Camera: Topcon TRC-NW8 — 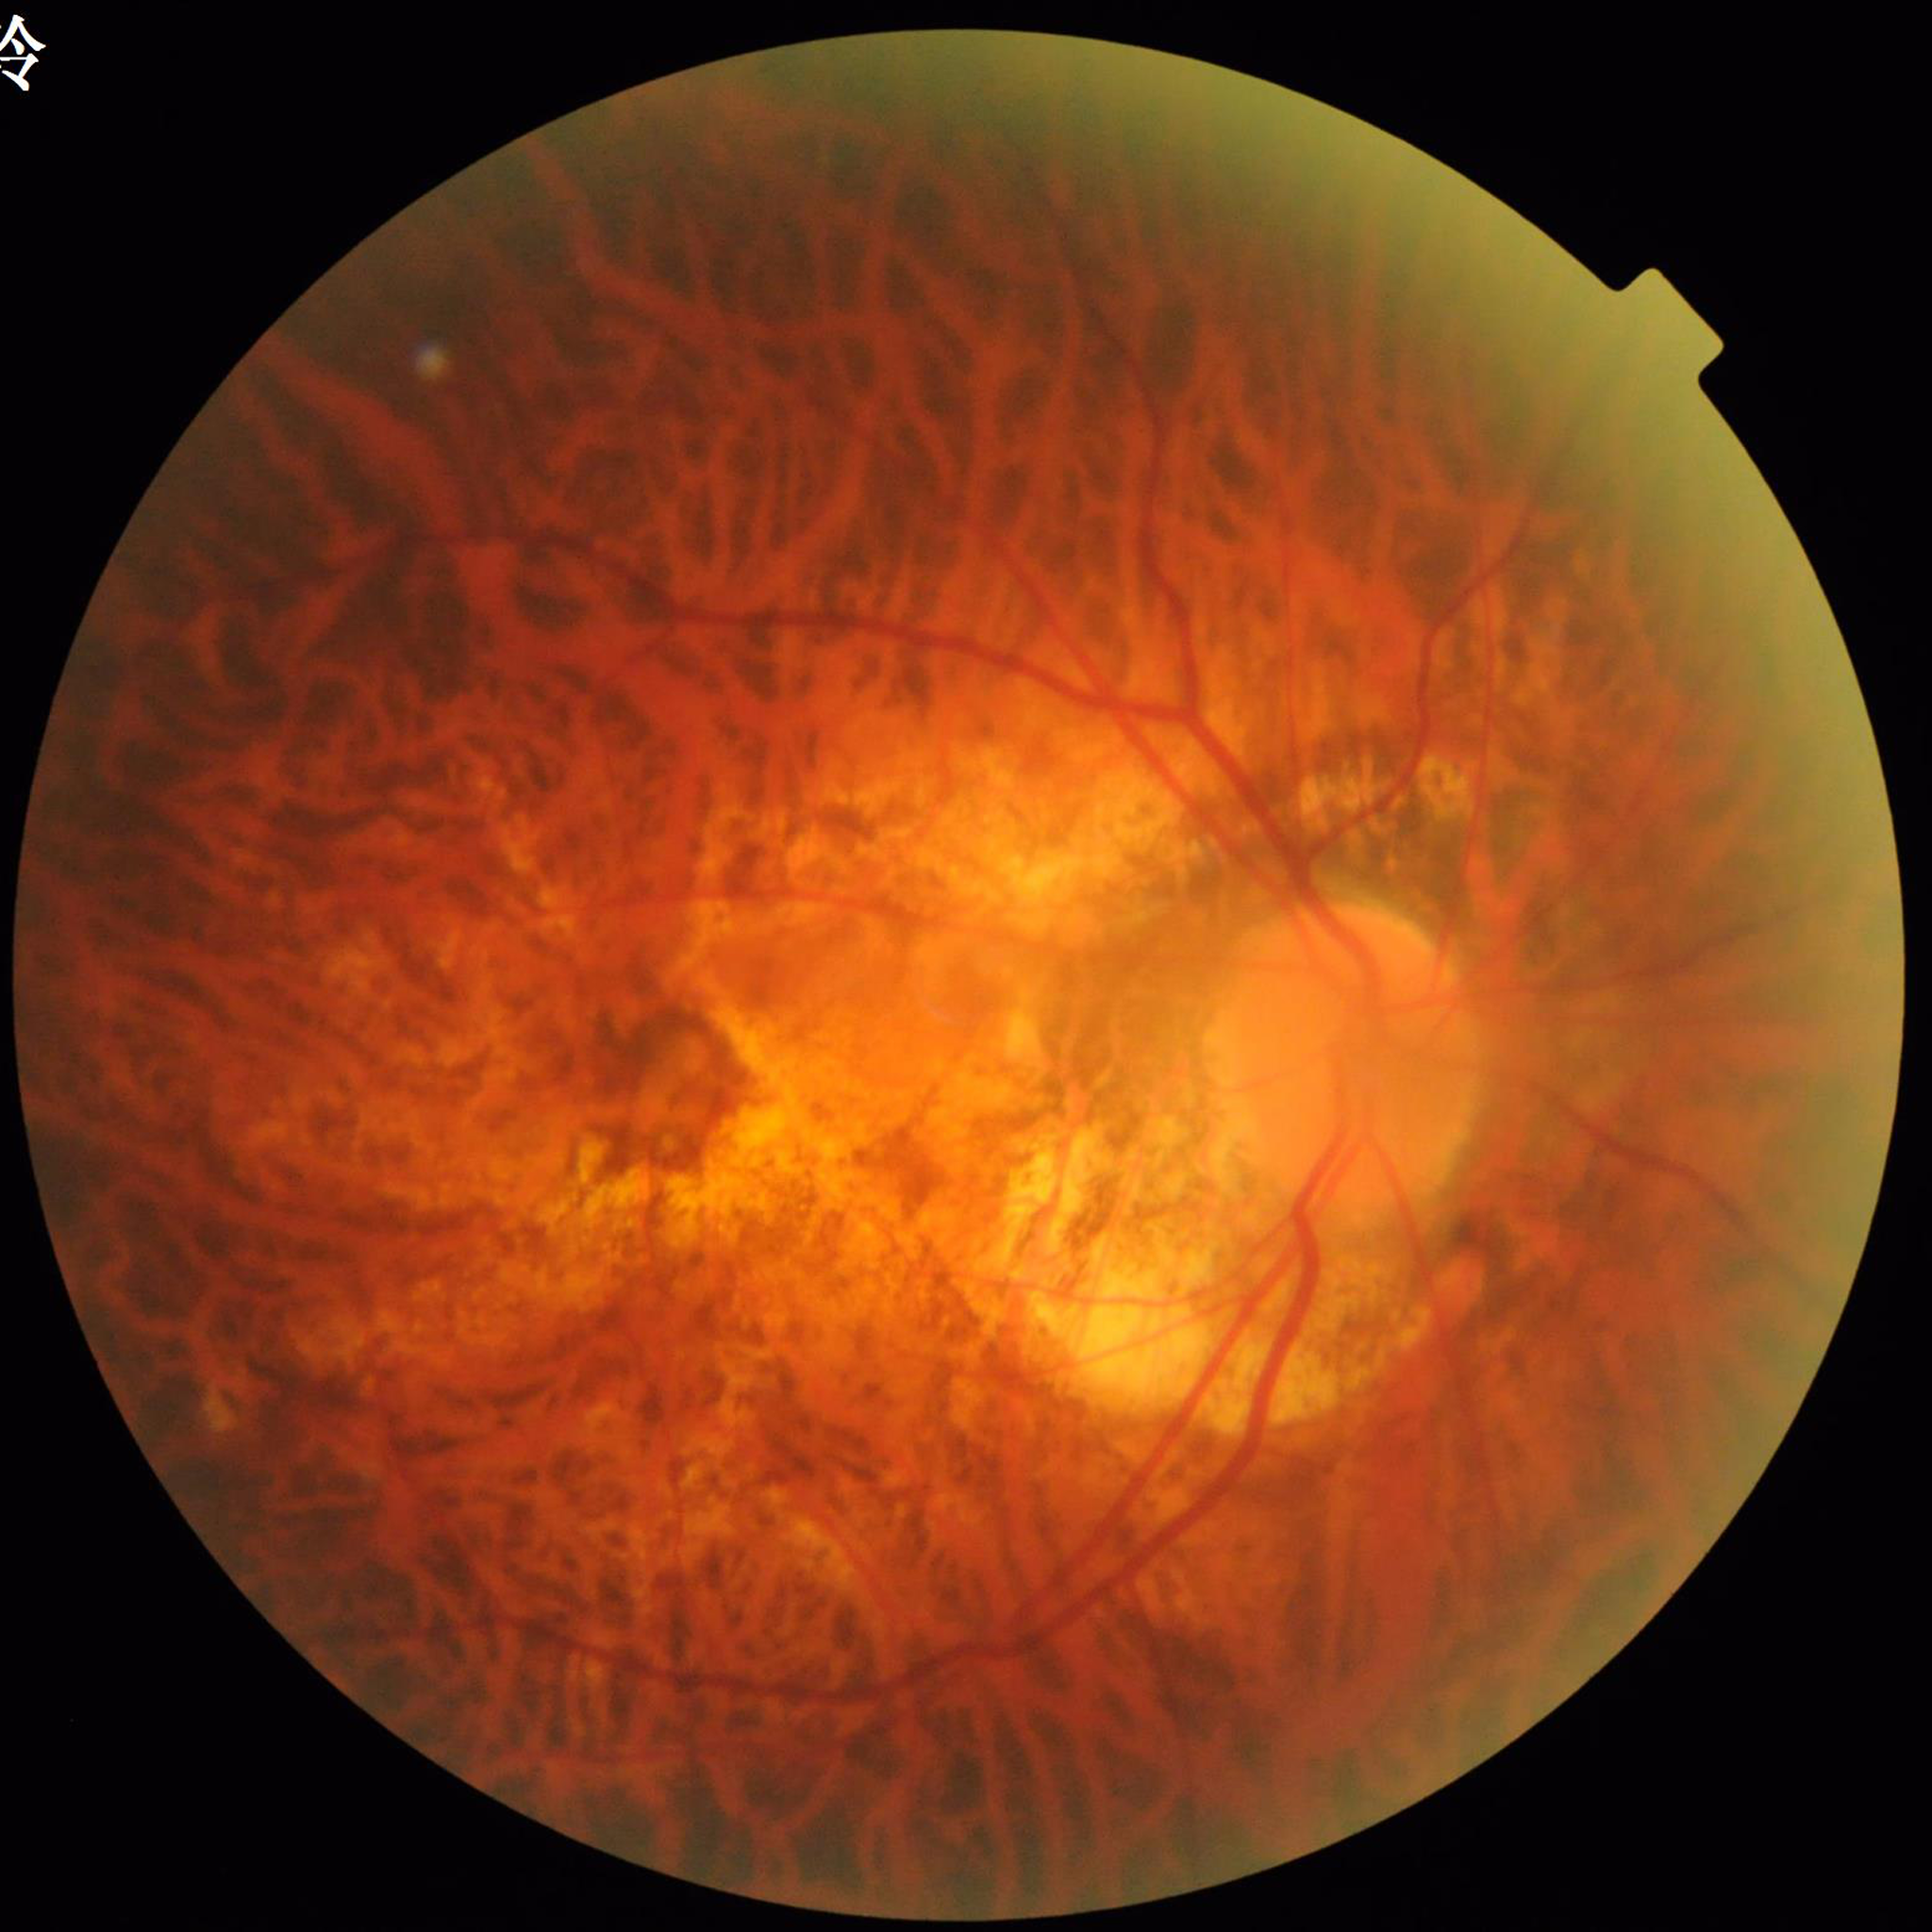 diagnosis: age-related macular degeneration